Posterior pole color fundus photograph · nonmydriatic fundus photograph: 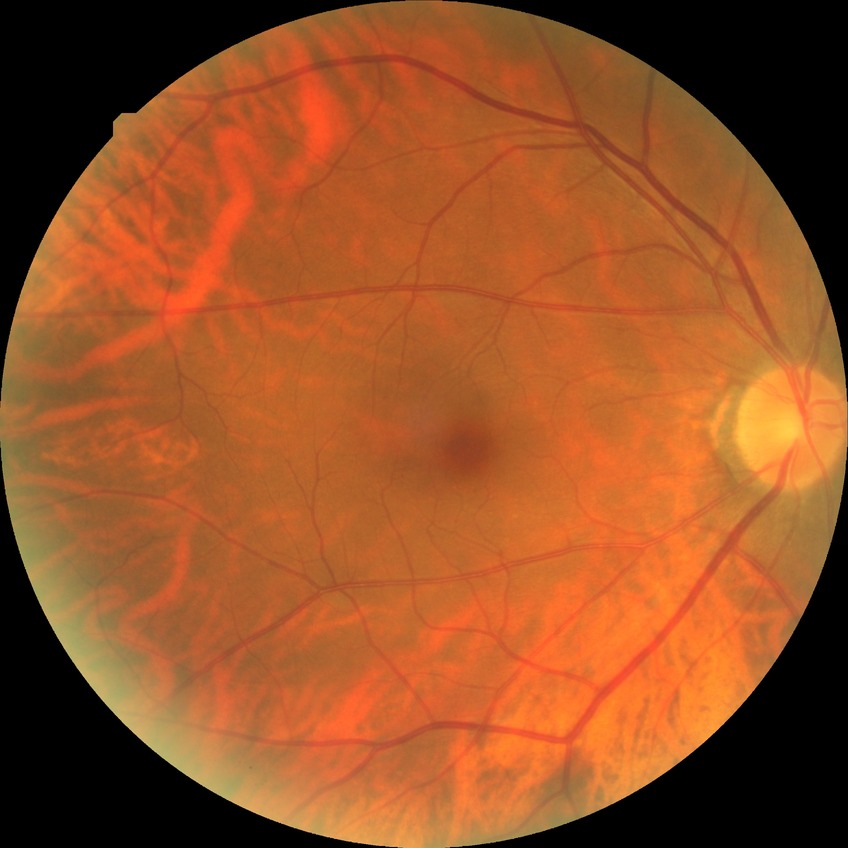

Diabetic retinopathy (DR) is no diabetic retinopathy (NDR).